Nonmydriatic: 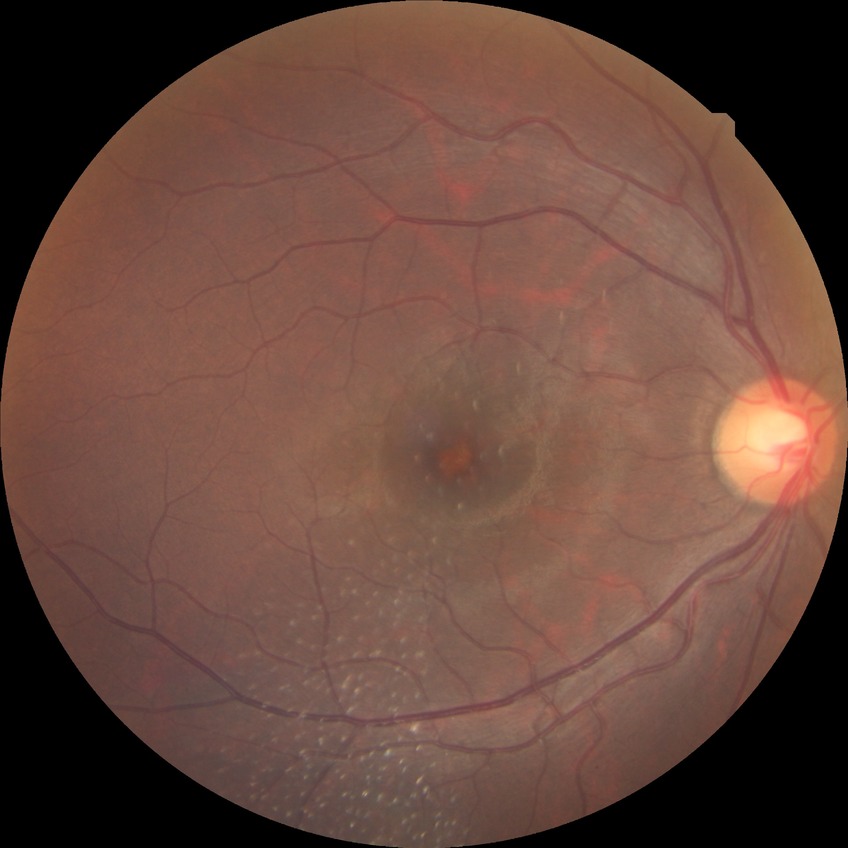
Diabetic retinopathy stage is no diabetic retinopathy.